Image size 2352x1568:
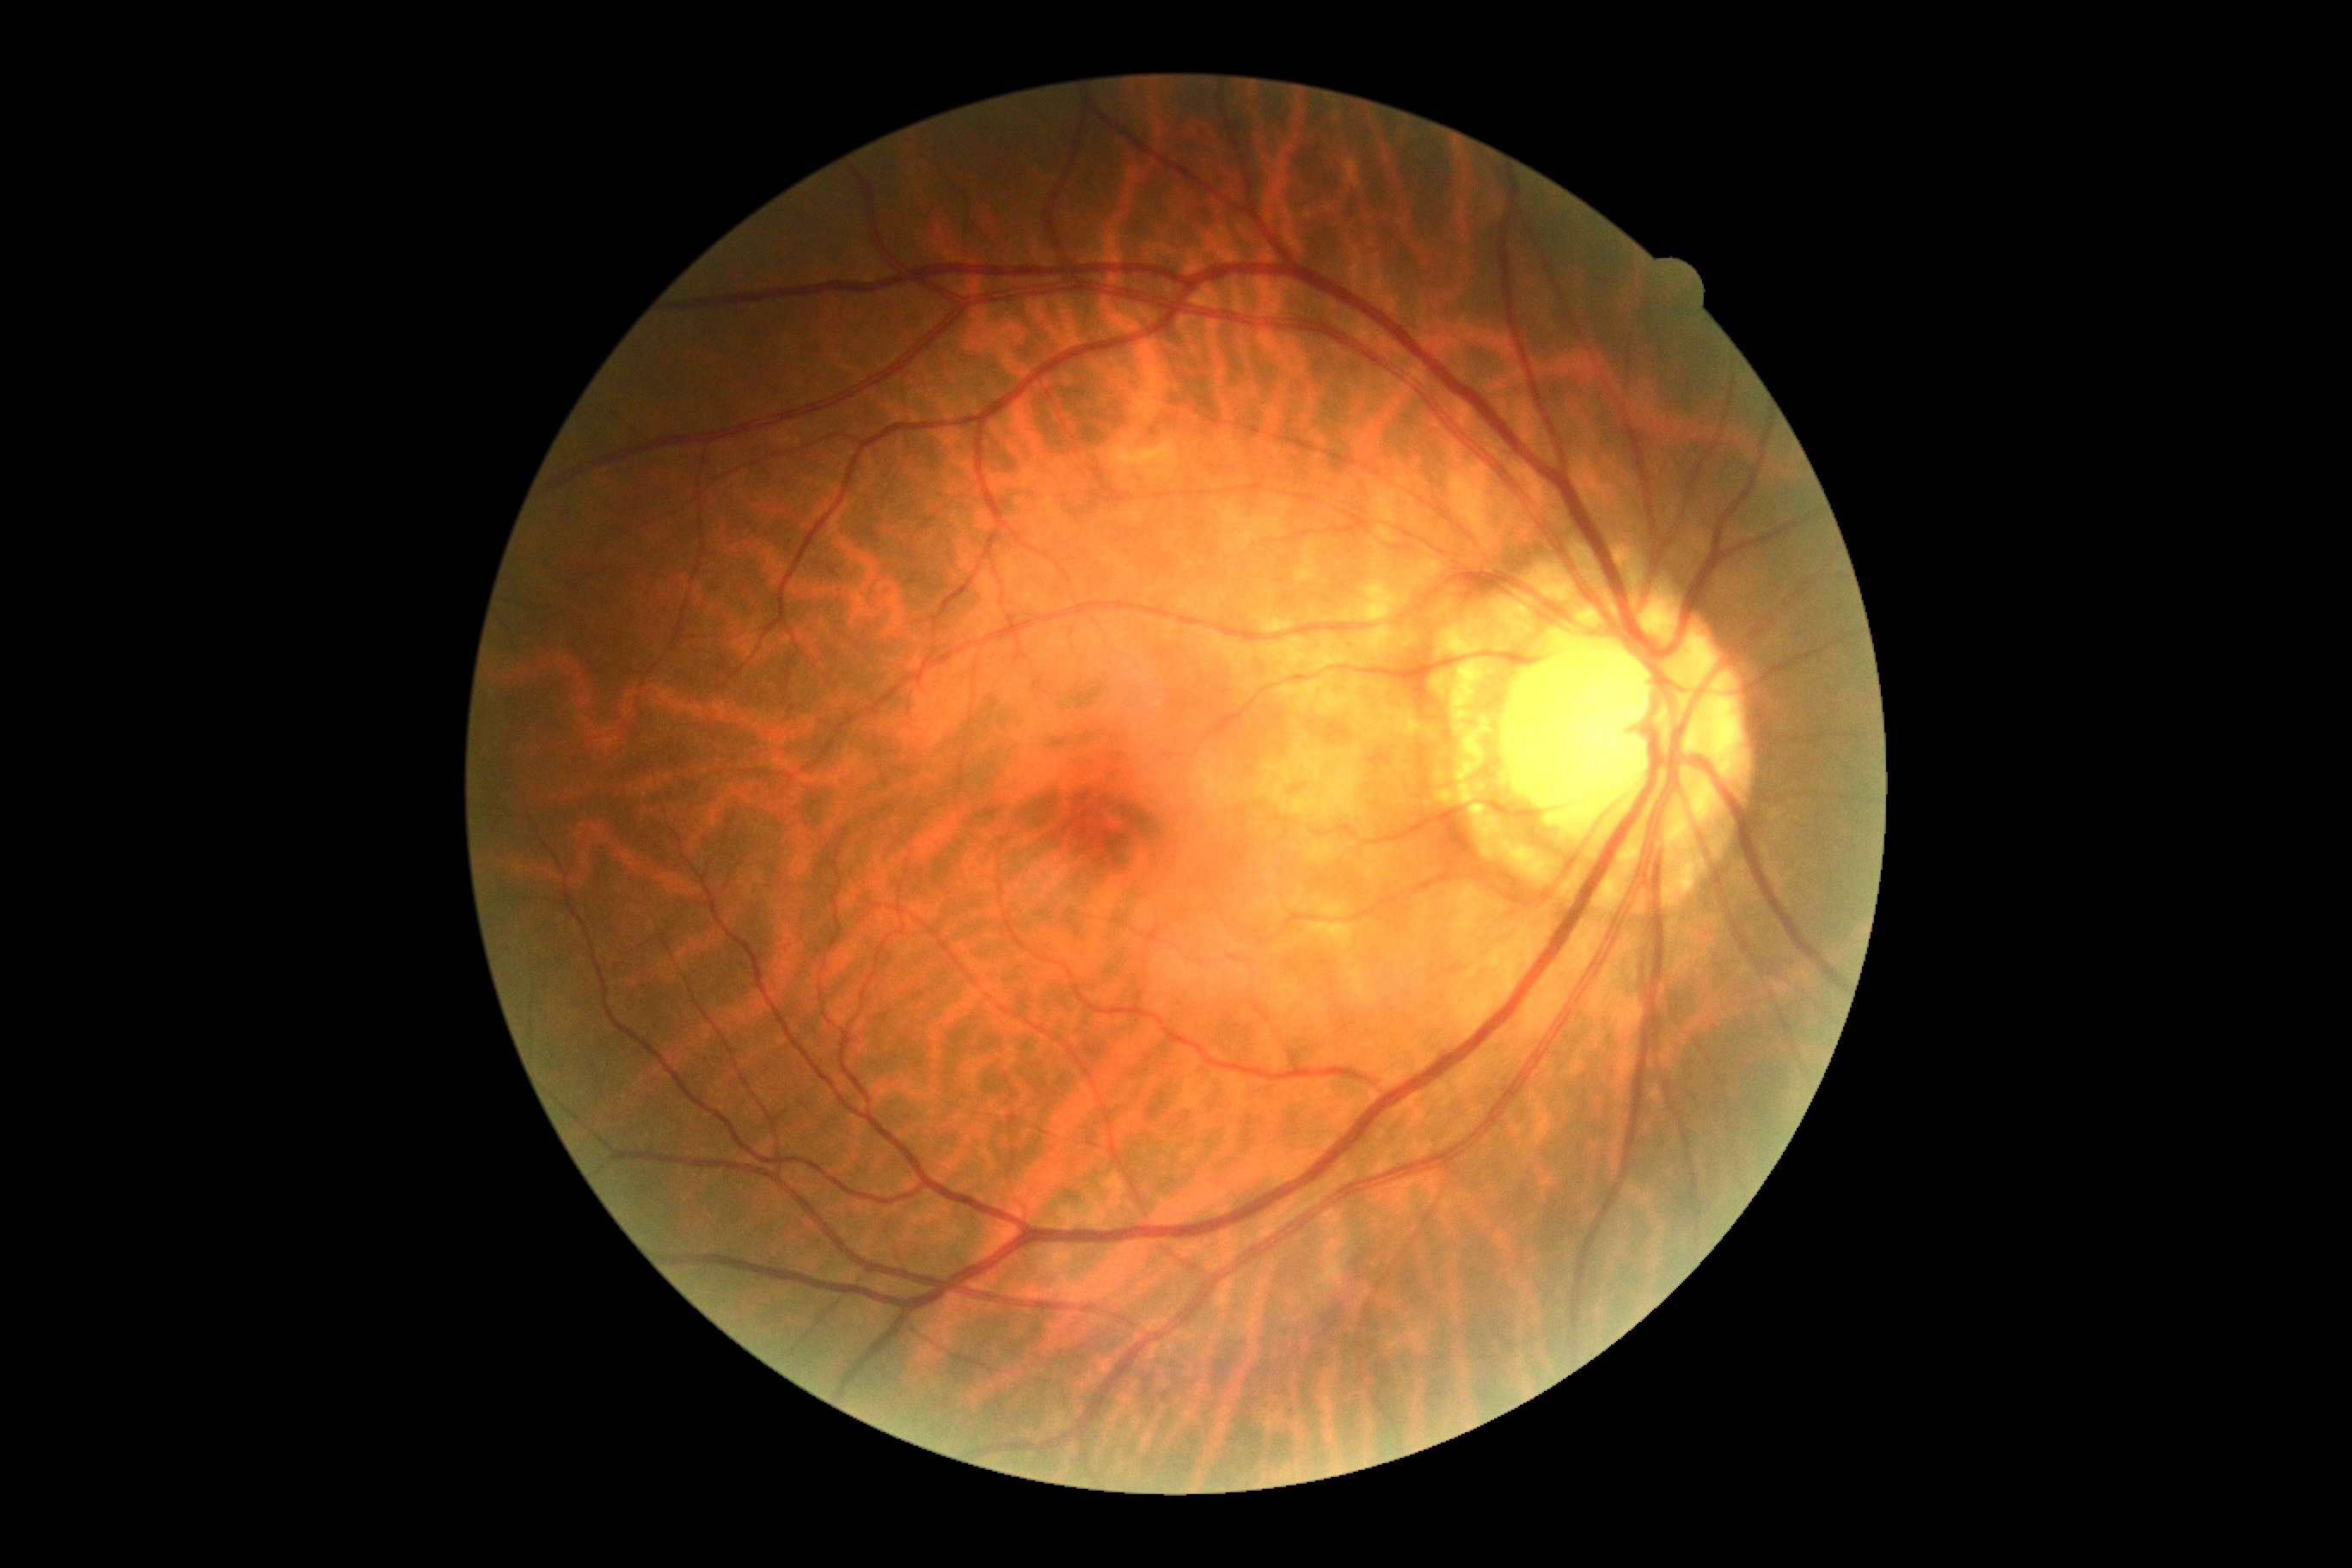 DR grade: 0